Modified Davis classification: 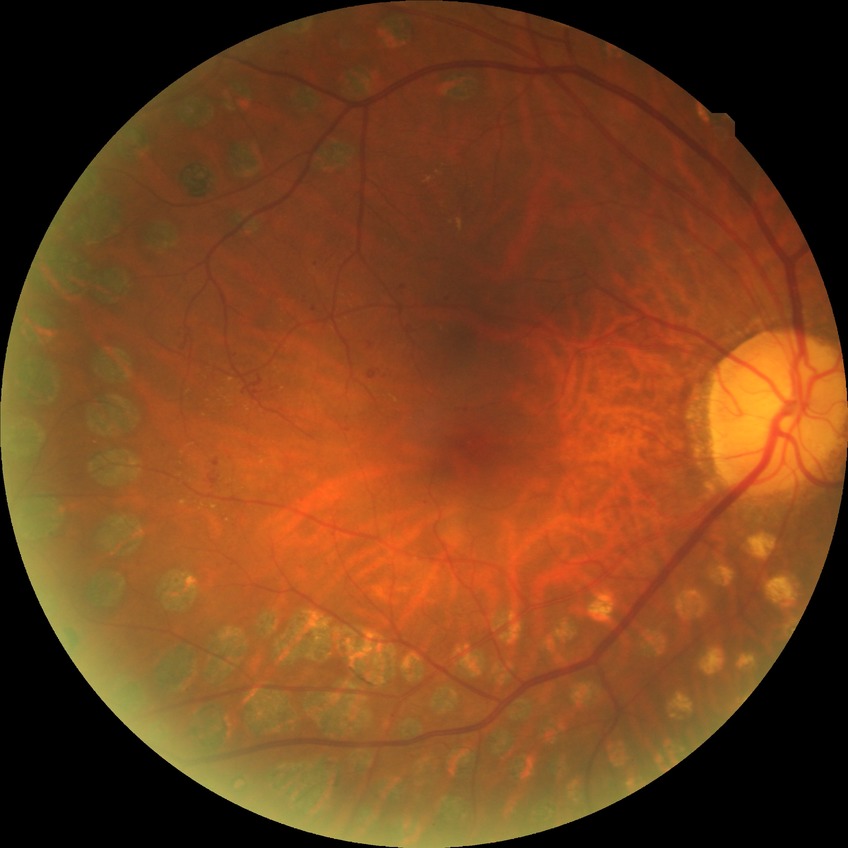 modified Davis grading: proliferative diabetic retinopathy.